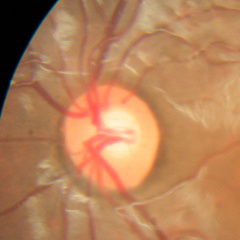 Glaucoma diagnosis: no signs of glaucoma.